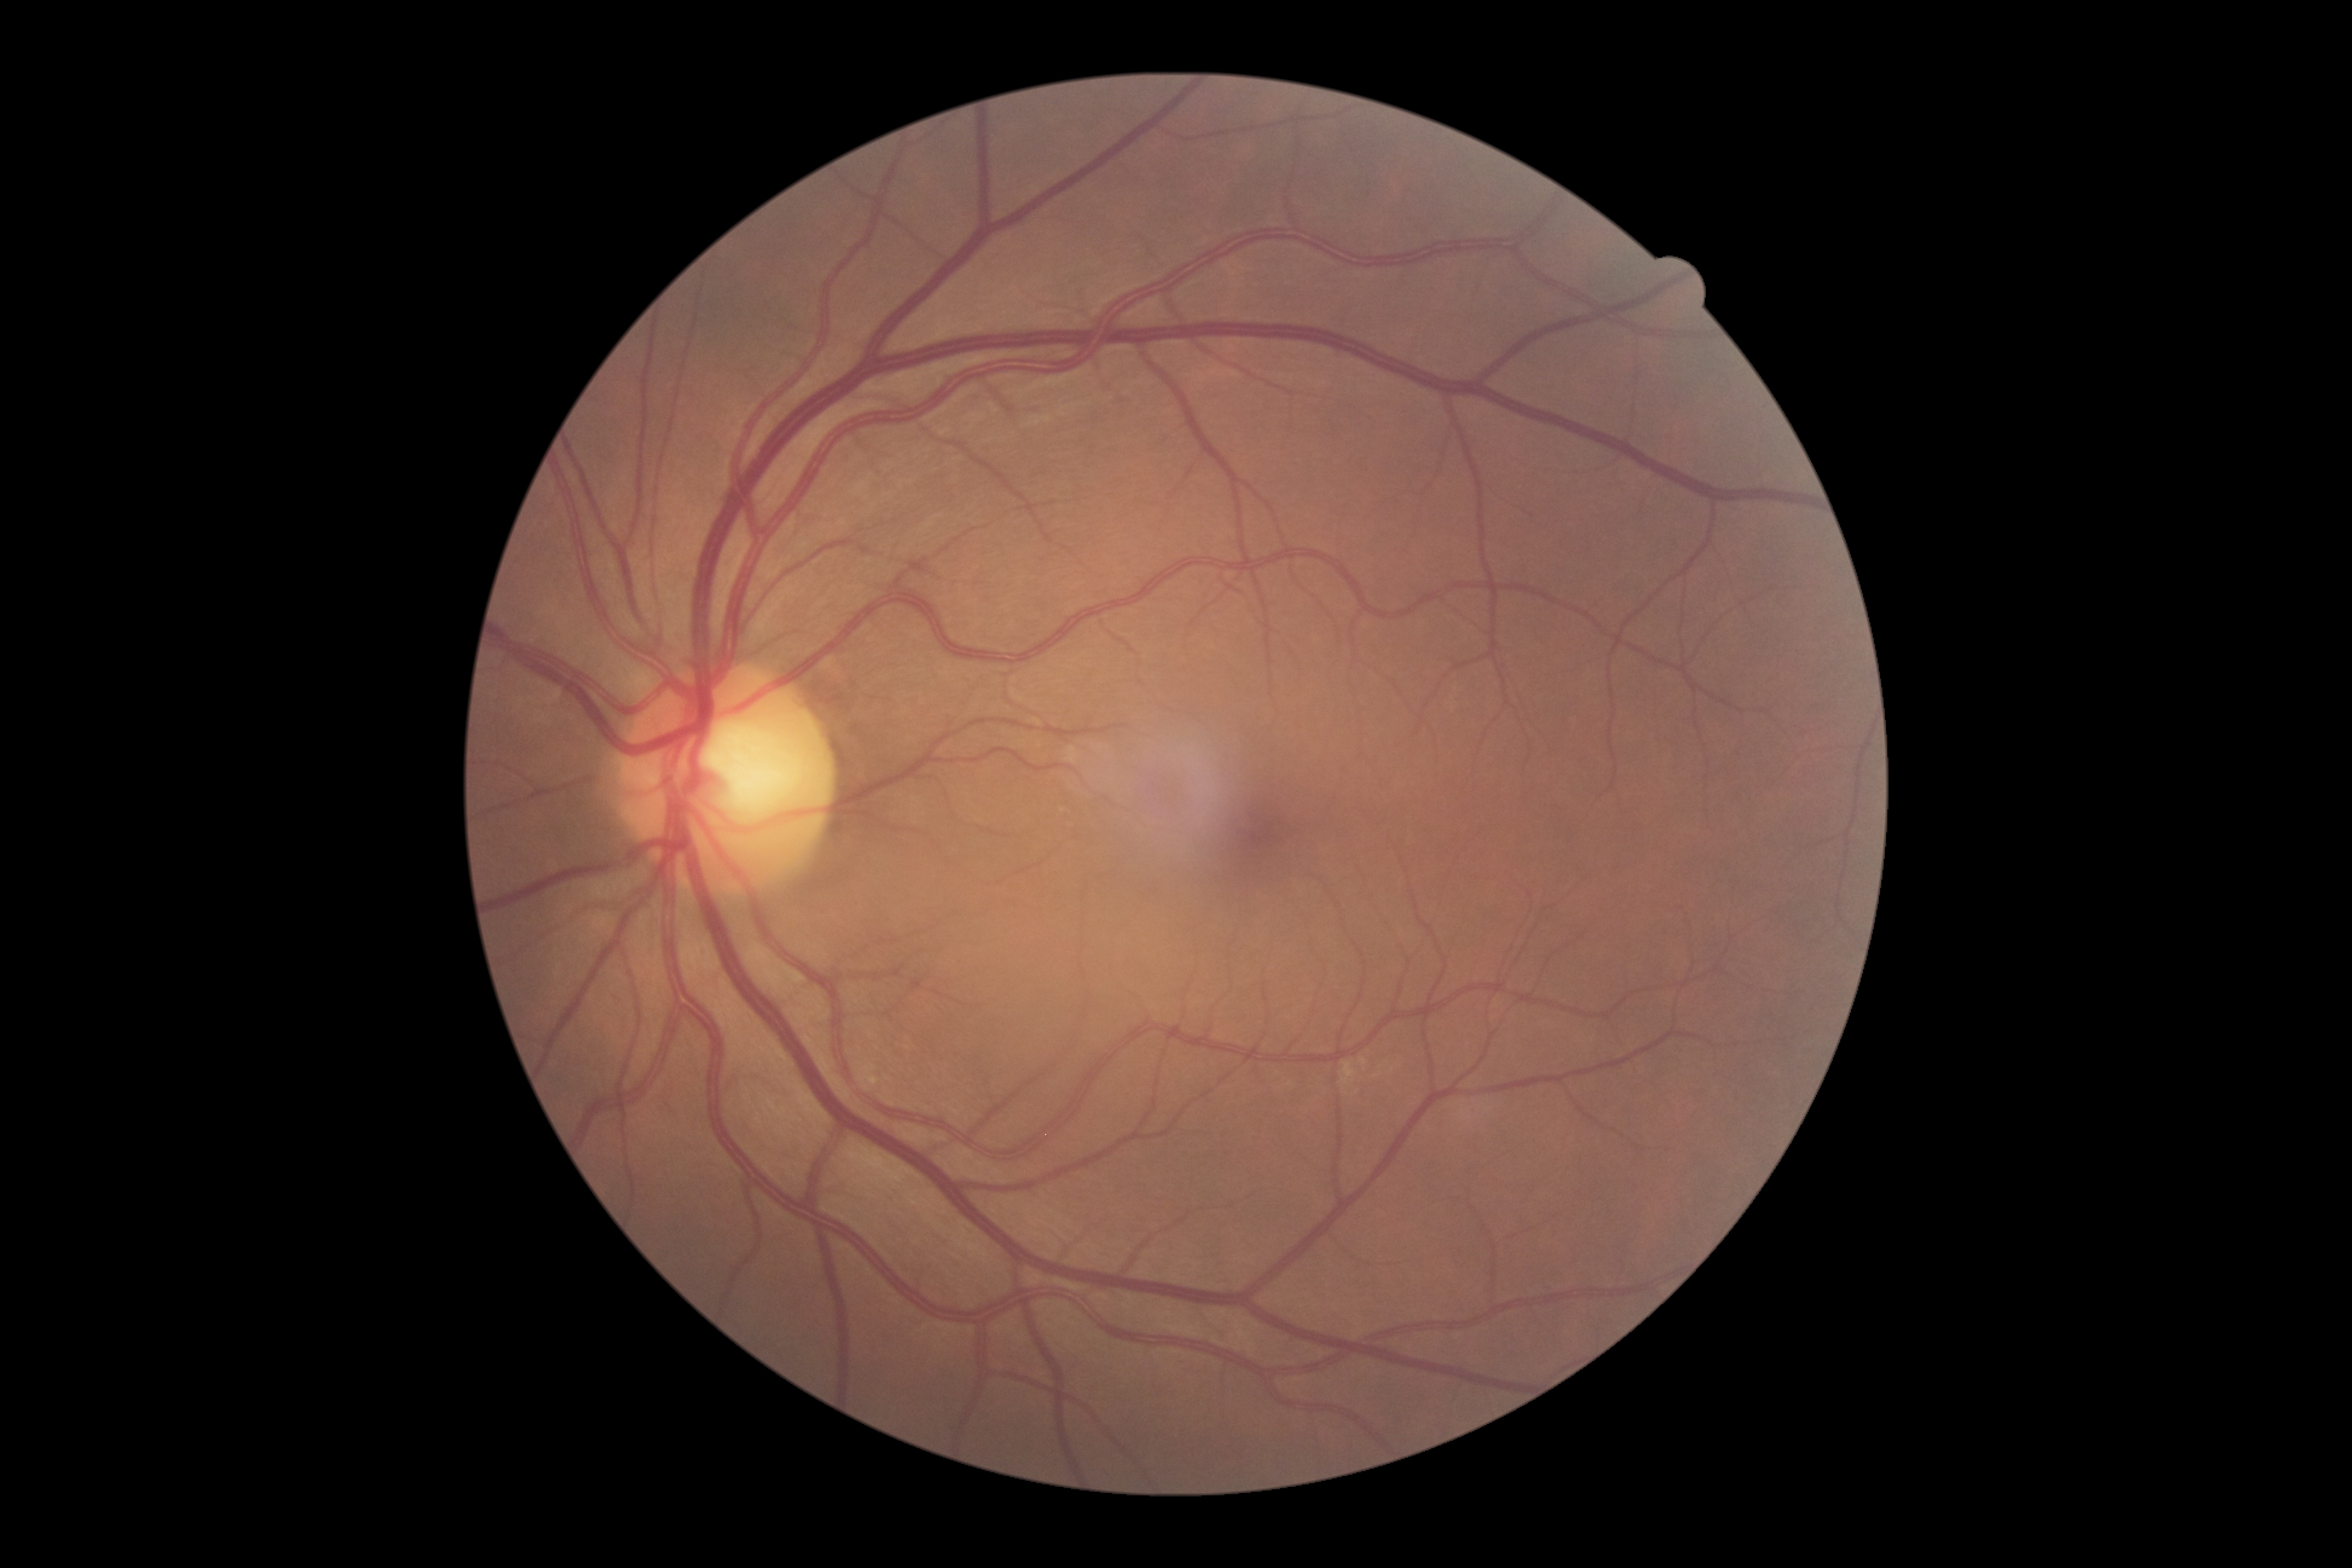
DR grade: no apparent retinopathy (0).